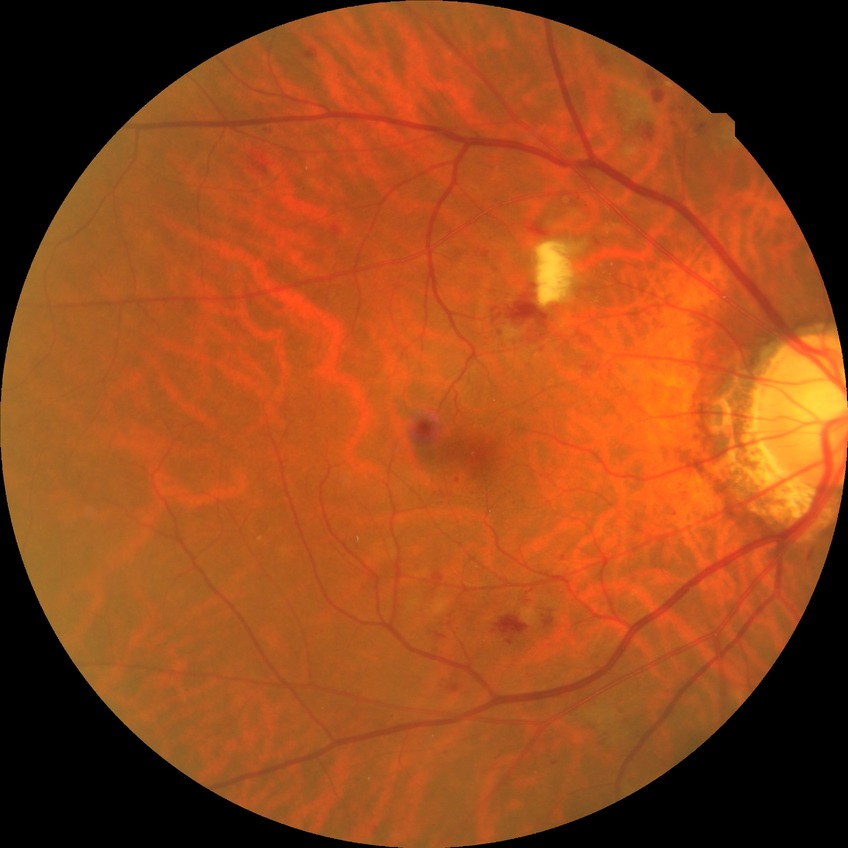

diabetic retinopathy (DR) = PPDR (pre-proliferative diabetic retinopathy).